Handheld portable fundus camera image
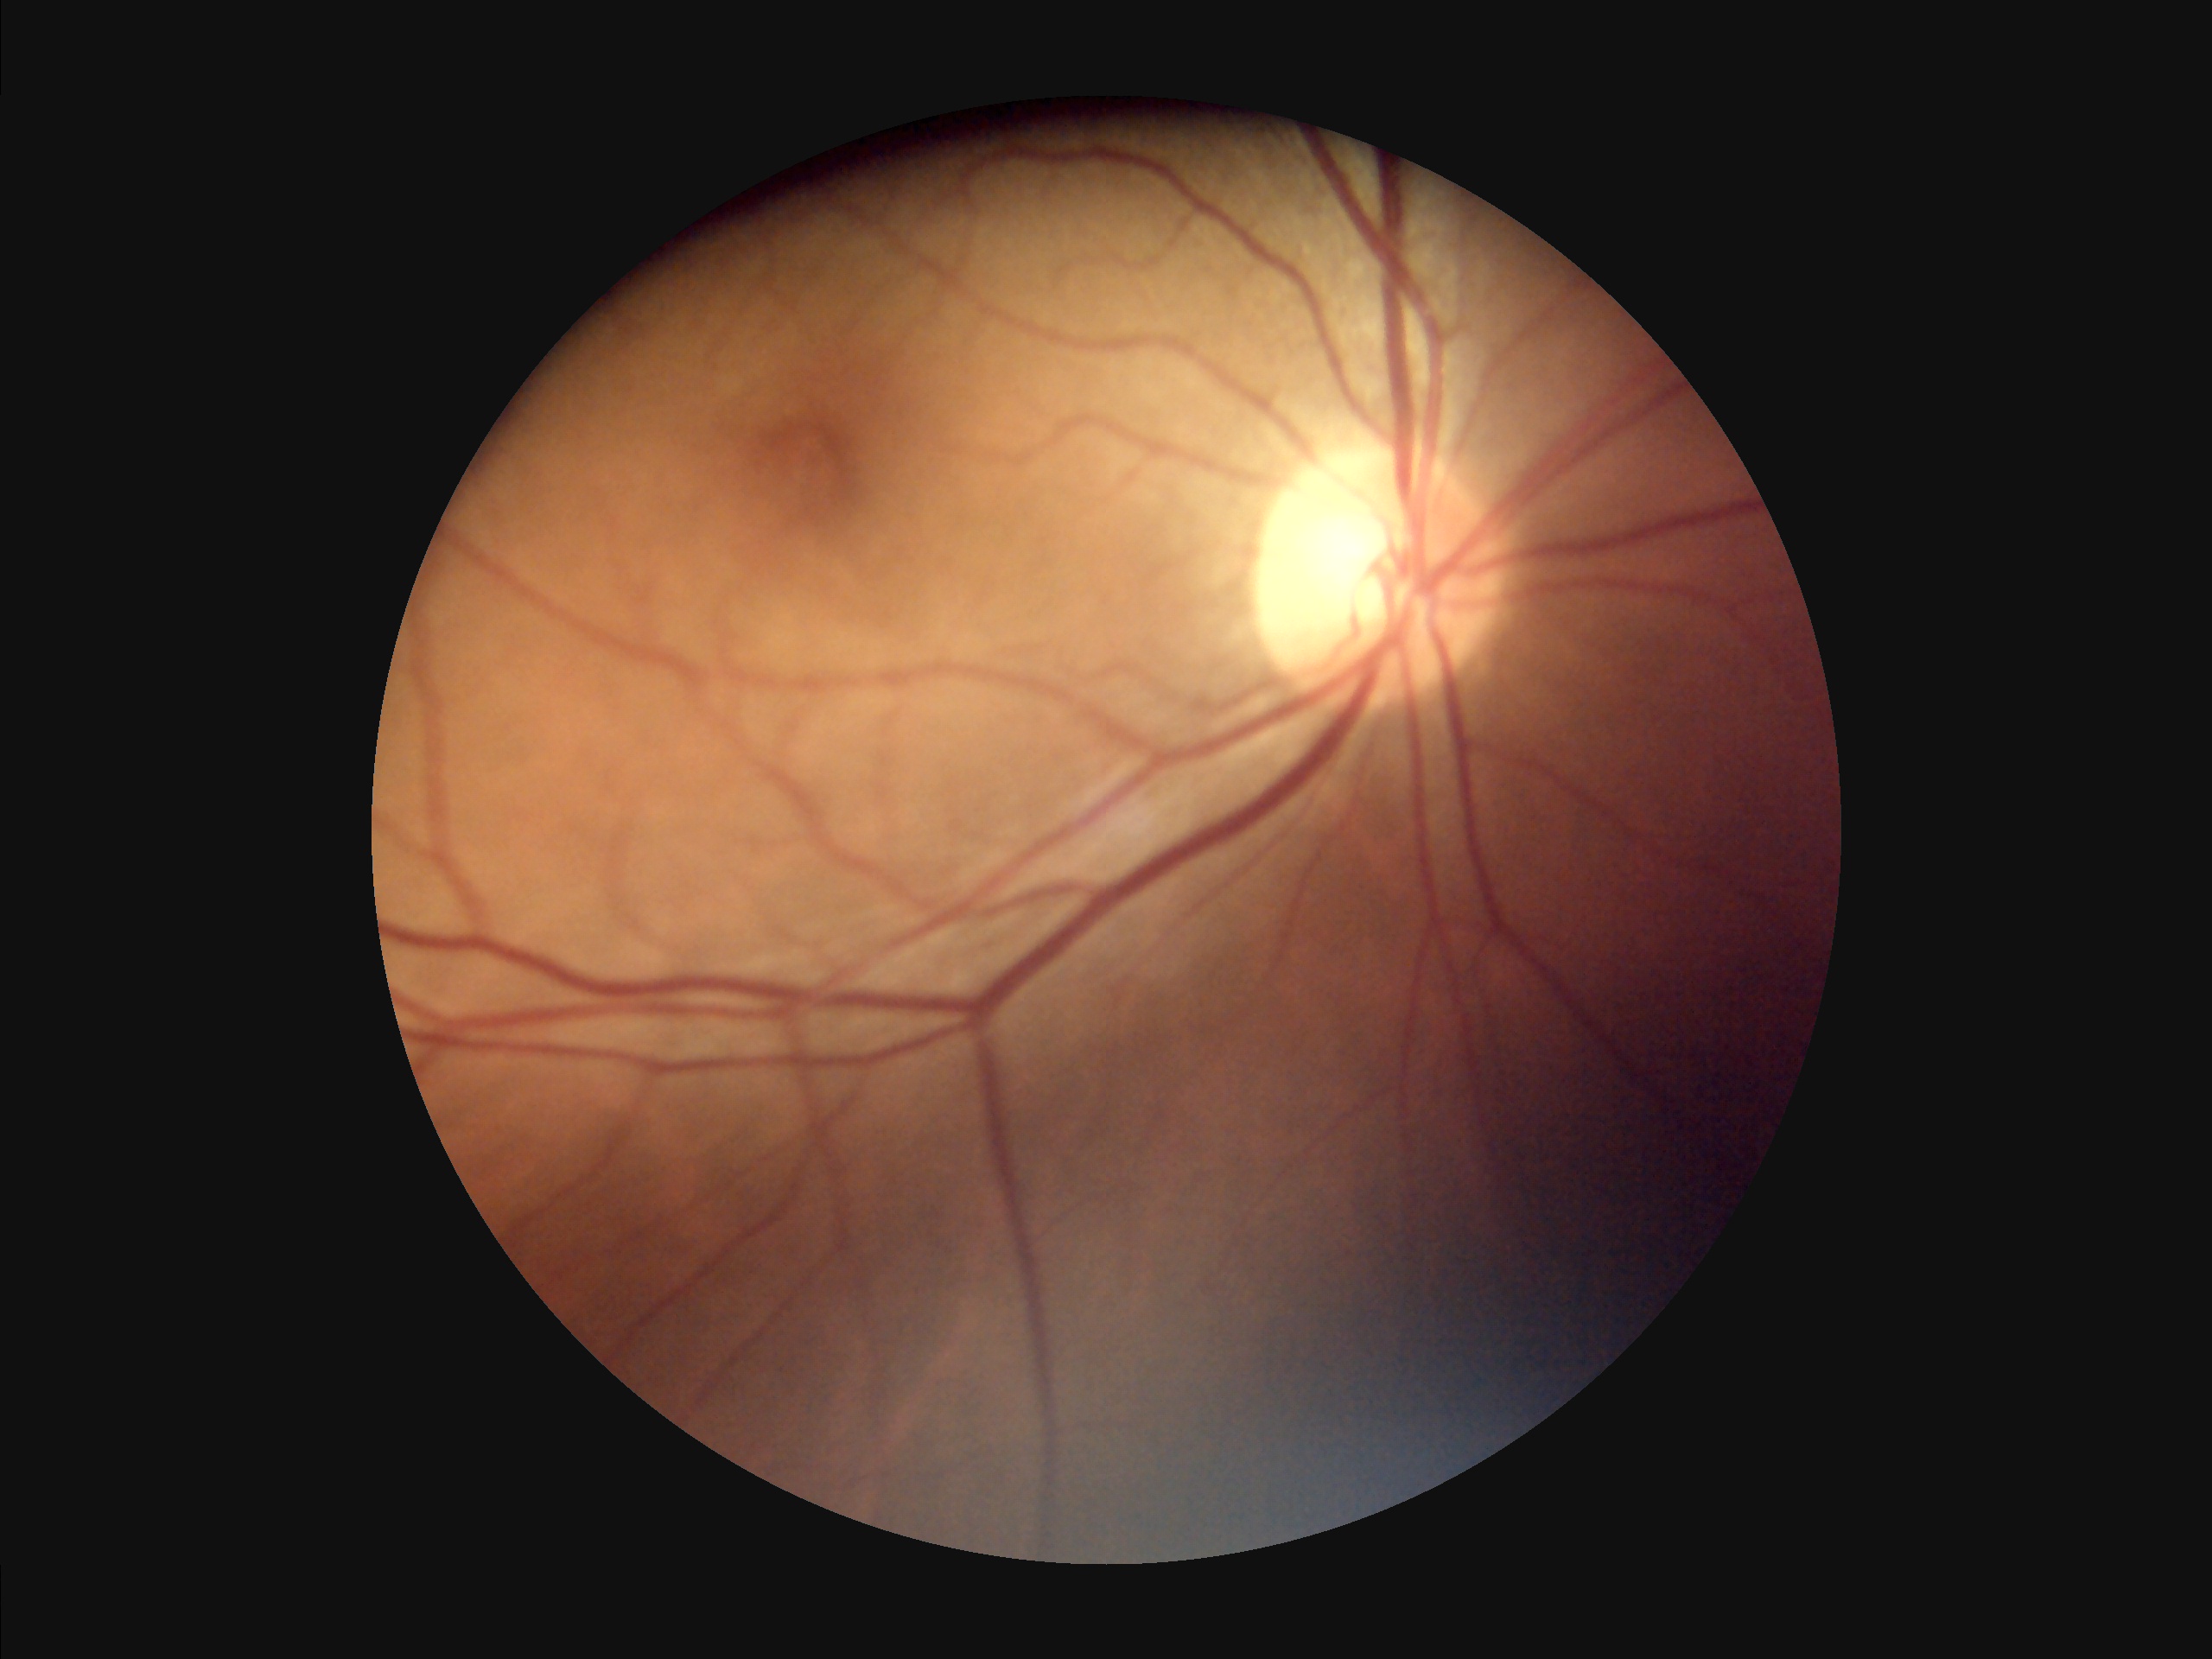
{
  "overall_quality": "acceptable",
  "illumination": "poor",
  "contrast": "satisfactory",
  "clarity": "sharp"
}